NIDEK AFC-230 fundus camera. No pharmacologic dilation. Graded on the modified Davis scale: 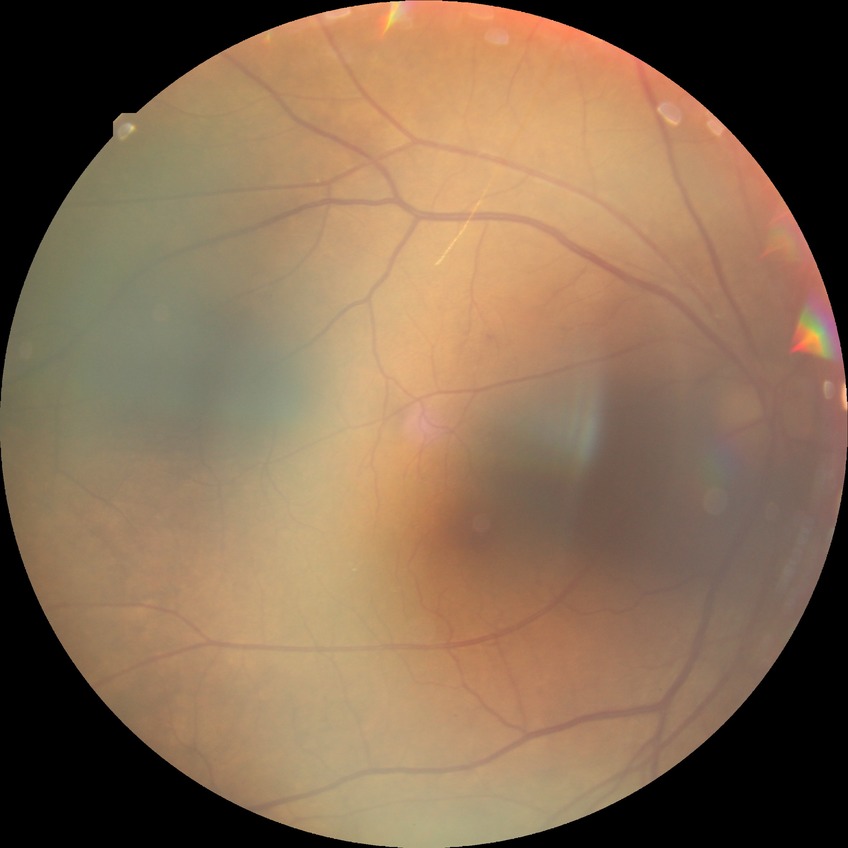

Diabetic retinopathy (DR) is no diabetic retinopathy (NDR).